Tabletop color fundus camera image — 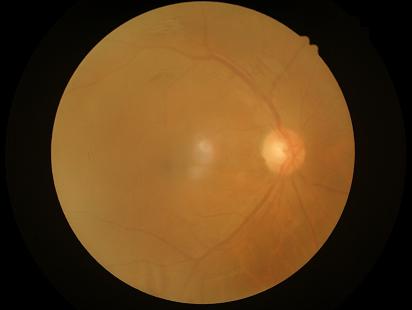
Image quality is suboptimal.
Out of focus; structures are indistinct.
Illumination and color balance are good.
Narrow intensity range; structures are hard to distinguish.